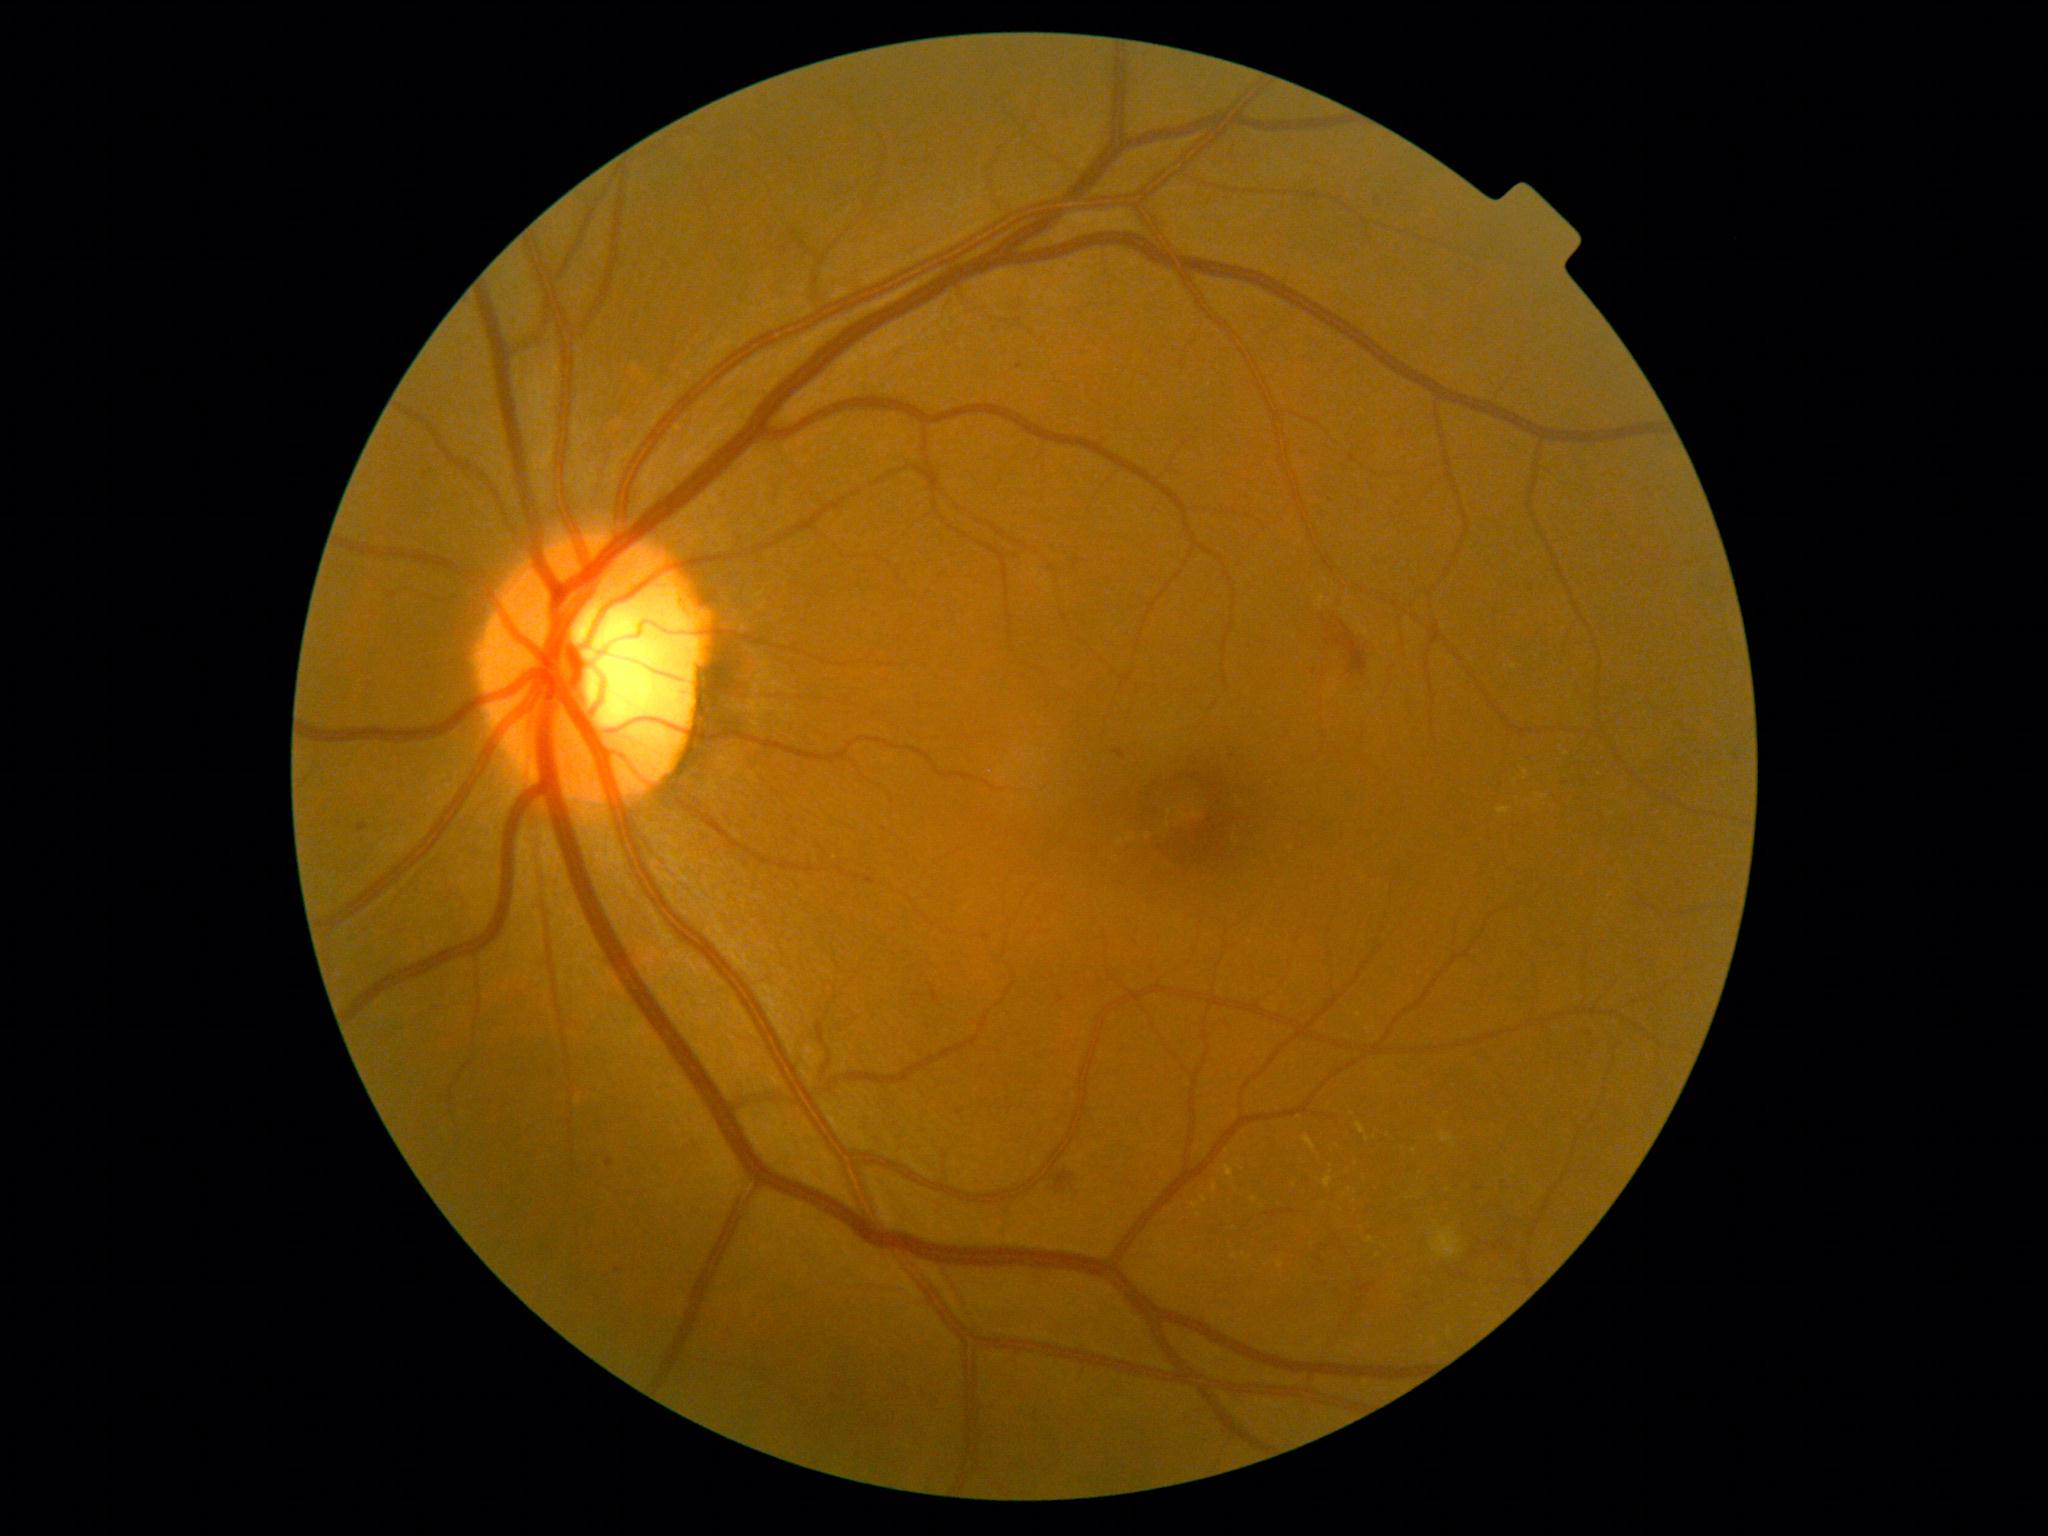 Diabetic retinopathy (DR) is grade 2 (moderate NPDR) — more than just microaneurysms but less than severe NPDR
Representative lesions:
- hard exudates (EXs) (subset): (1523, 770, 1529, 780), (1202, 1196, 1208, 1204), (1348, 1192, 1354, 1212), (1225, 1166, 1234, 1178), (1324, 1176, 1332, 1189)
- Smaller EXs around point(1255, 1200), point(1567, 754), point(1215, 1188), point(1244, 1256), point(1331, 1166), point(1375, 1255), point(1383, 1247)